FOV: 45 degrees. NIDEK AFC-230 fundus camera. Color fundus image.
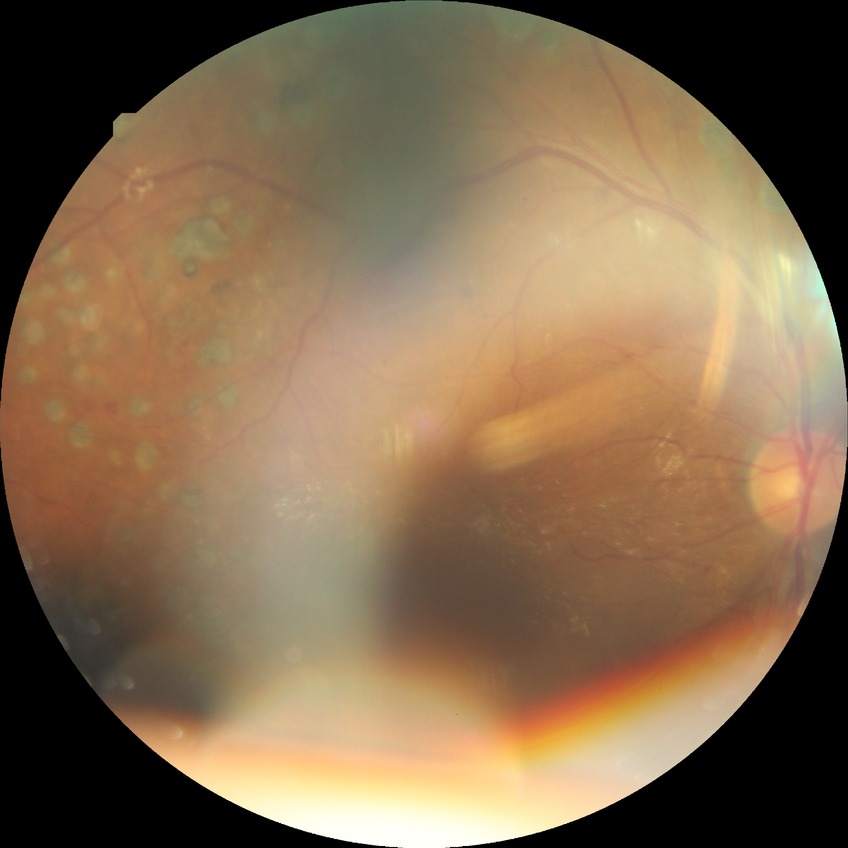

Modified Davis grade: PDR.